848 x 848 pixels · color fundus image · acquired with a NIDEK AFC-230:
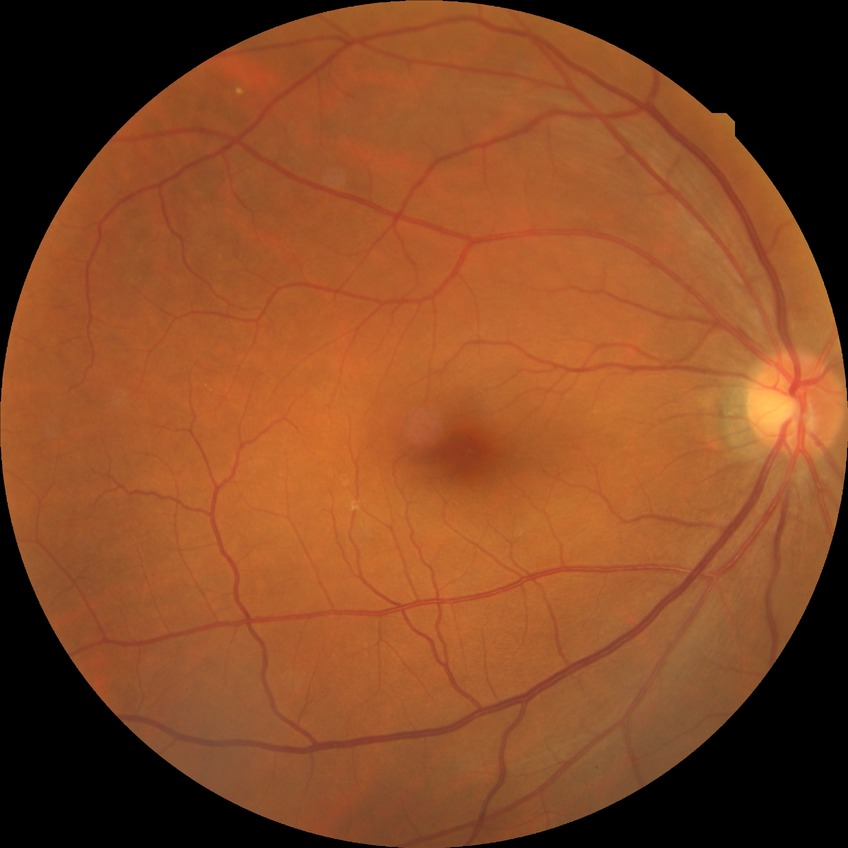 {
  "davis_grade": "no diabetic retinopathy"
}